1932 x 1932 pixels
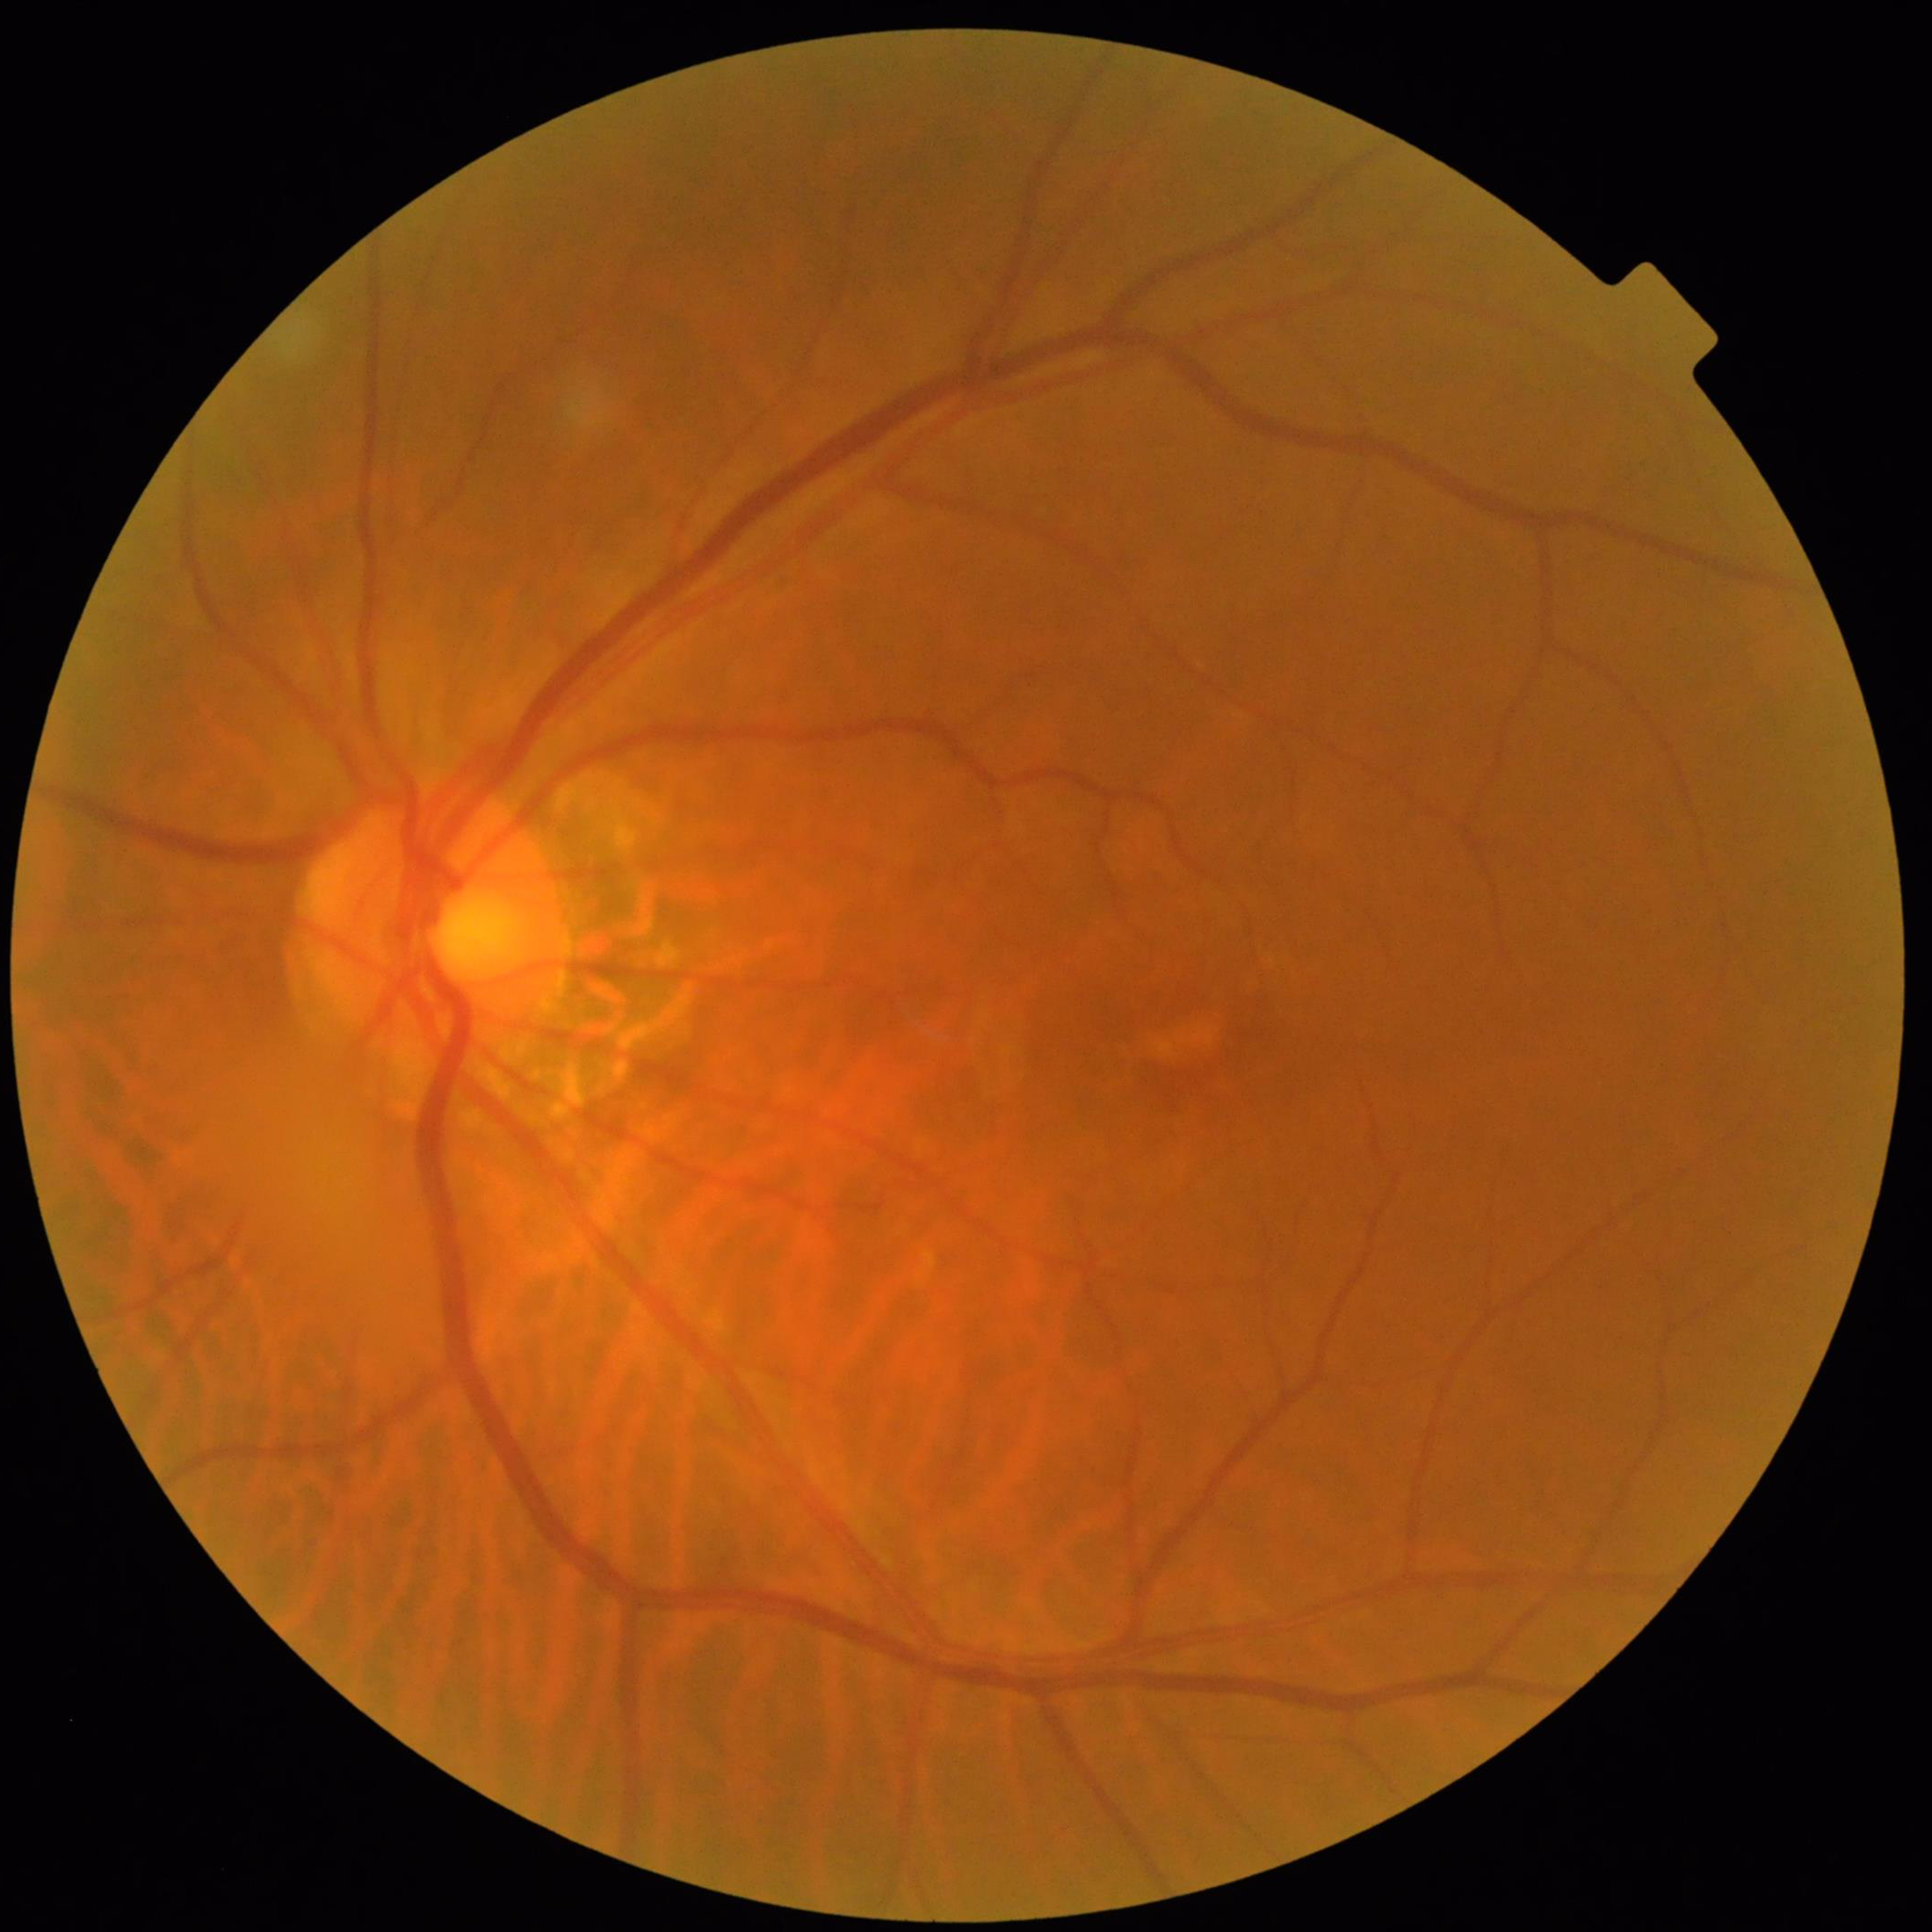
From a patient with diabetic retinopathy.